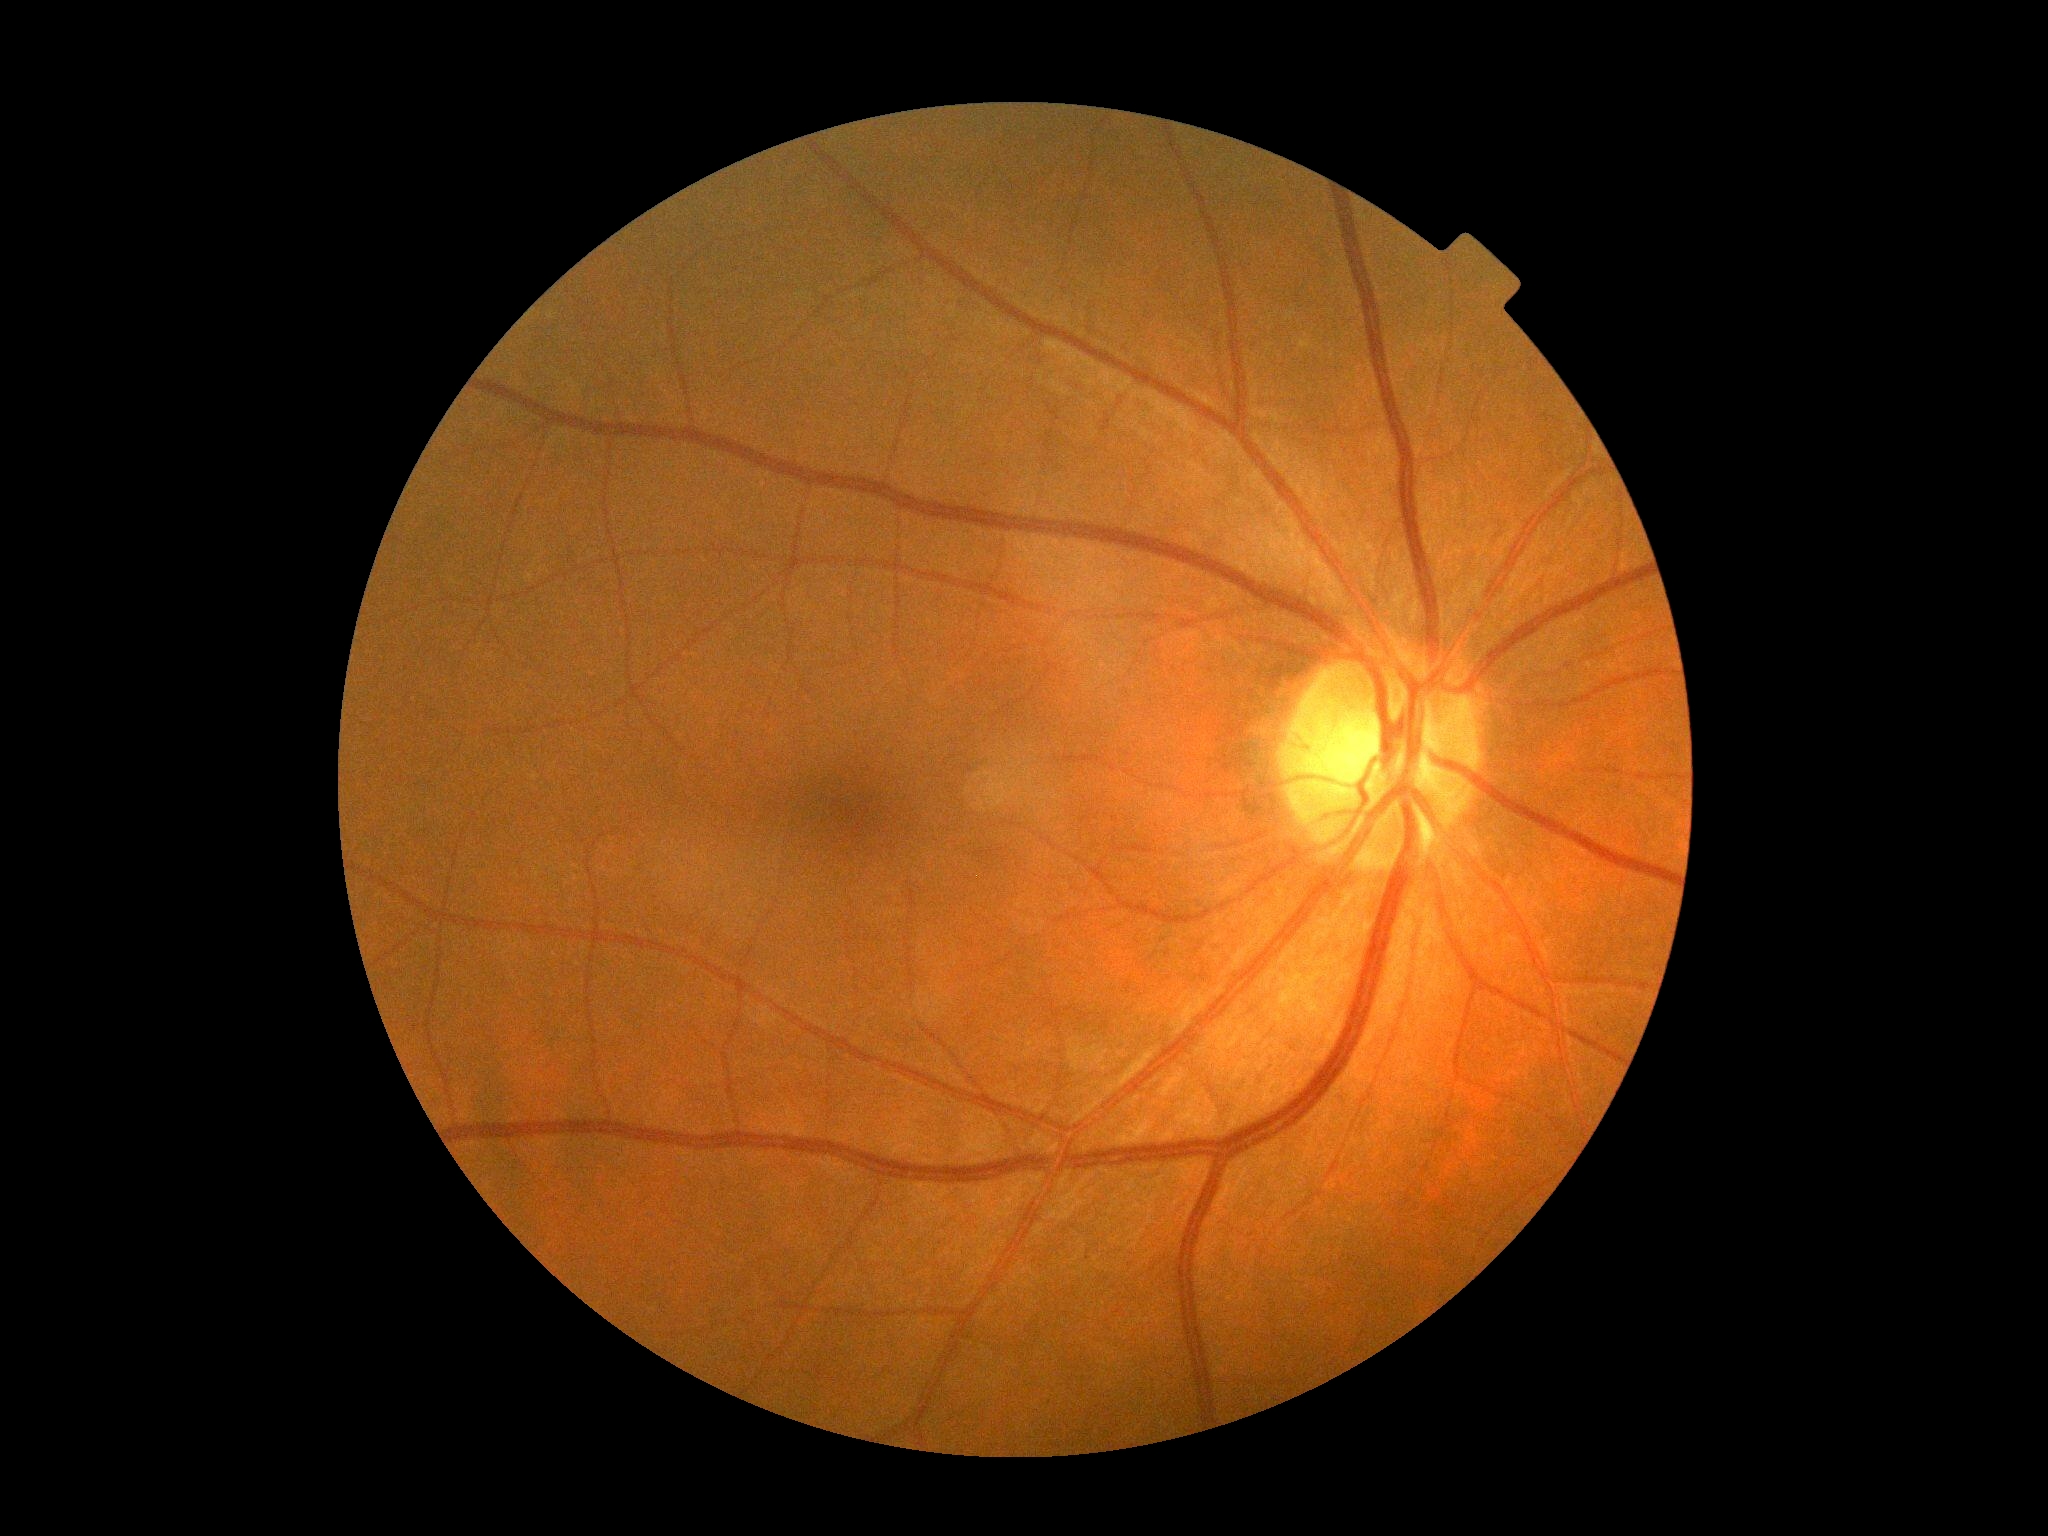

DR: grade 0 (no apparent retinopathy).